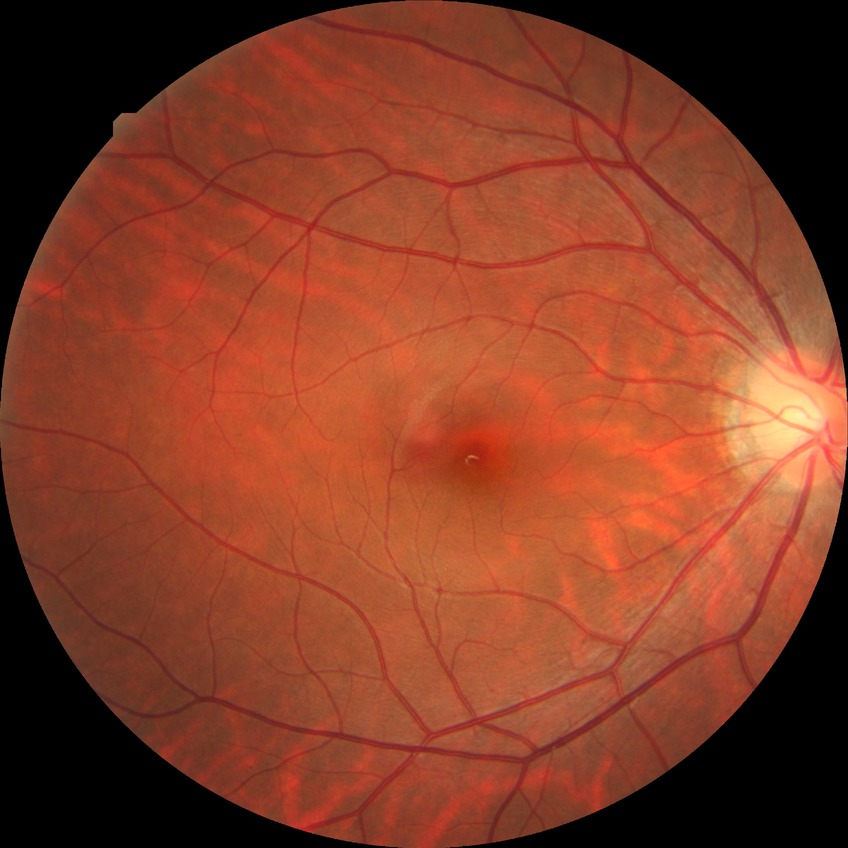 Diabetic retinopathy (DR) is NDR (no diabetic retinopathy).